Image size 2212x1662 · retinal fundus photograph · 45° field of view.
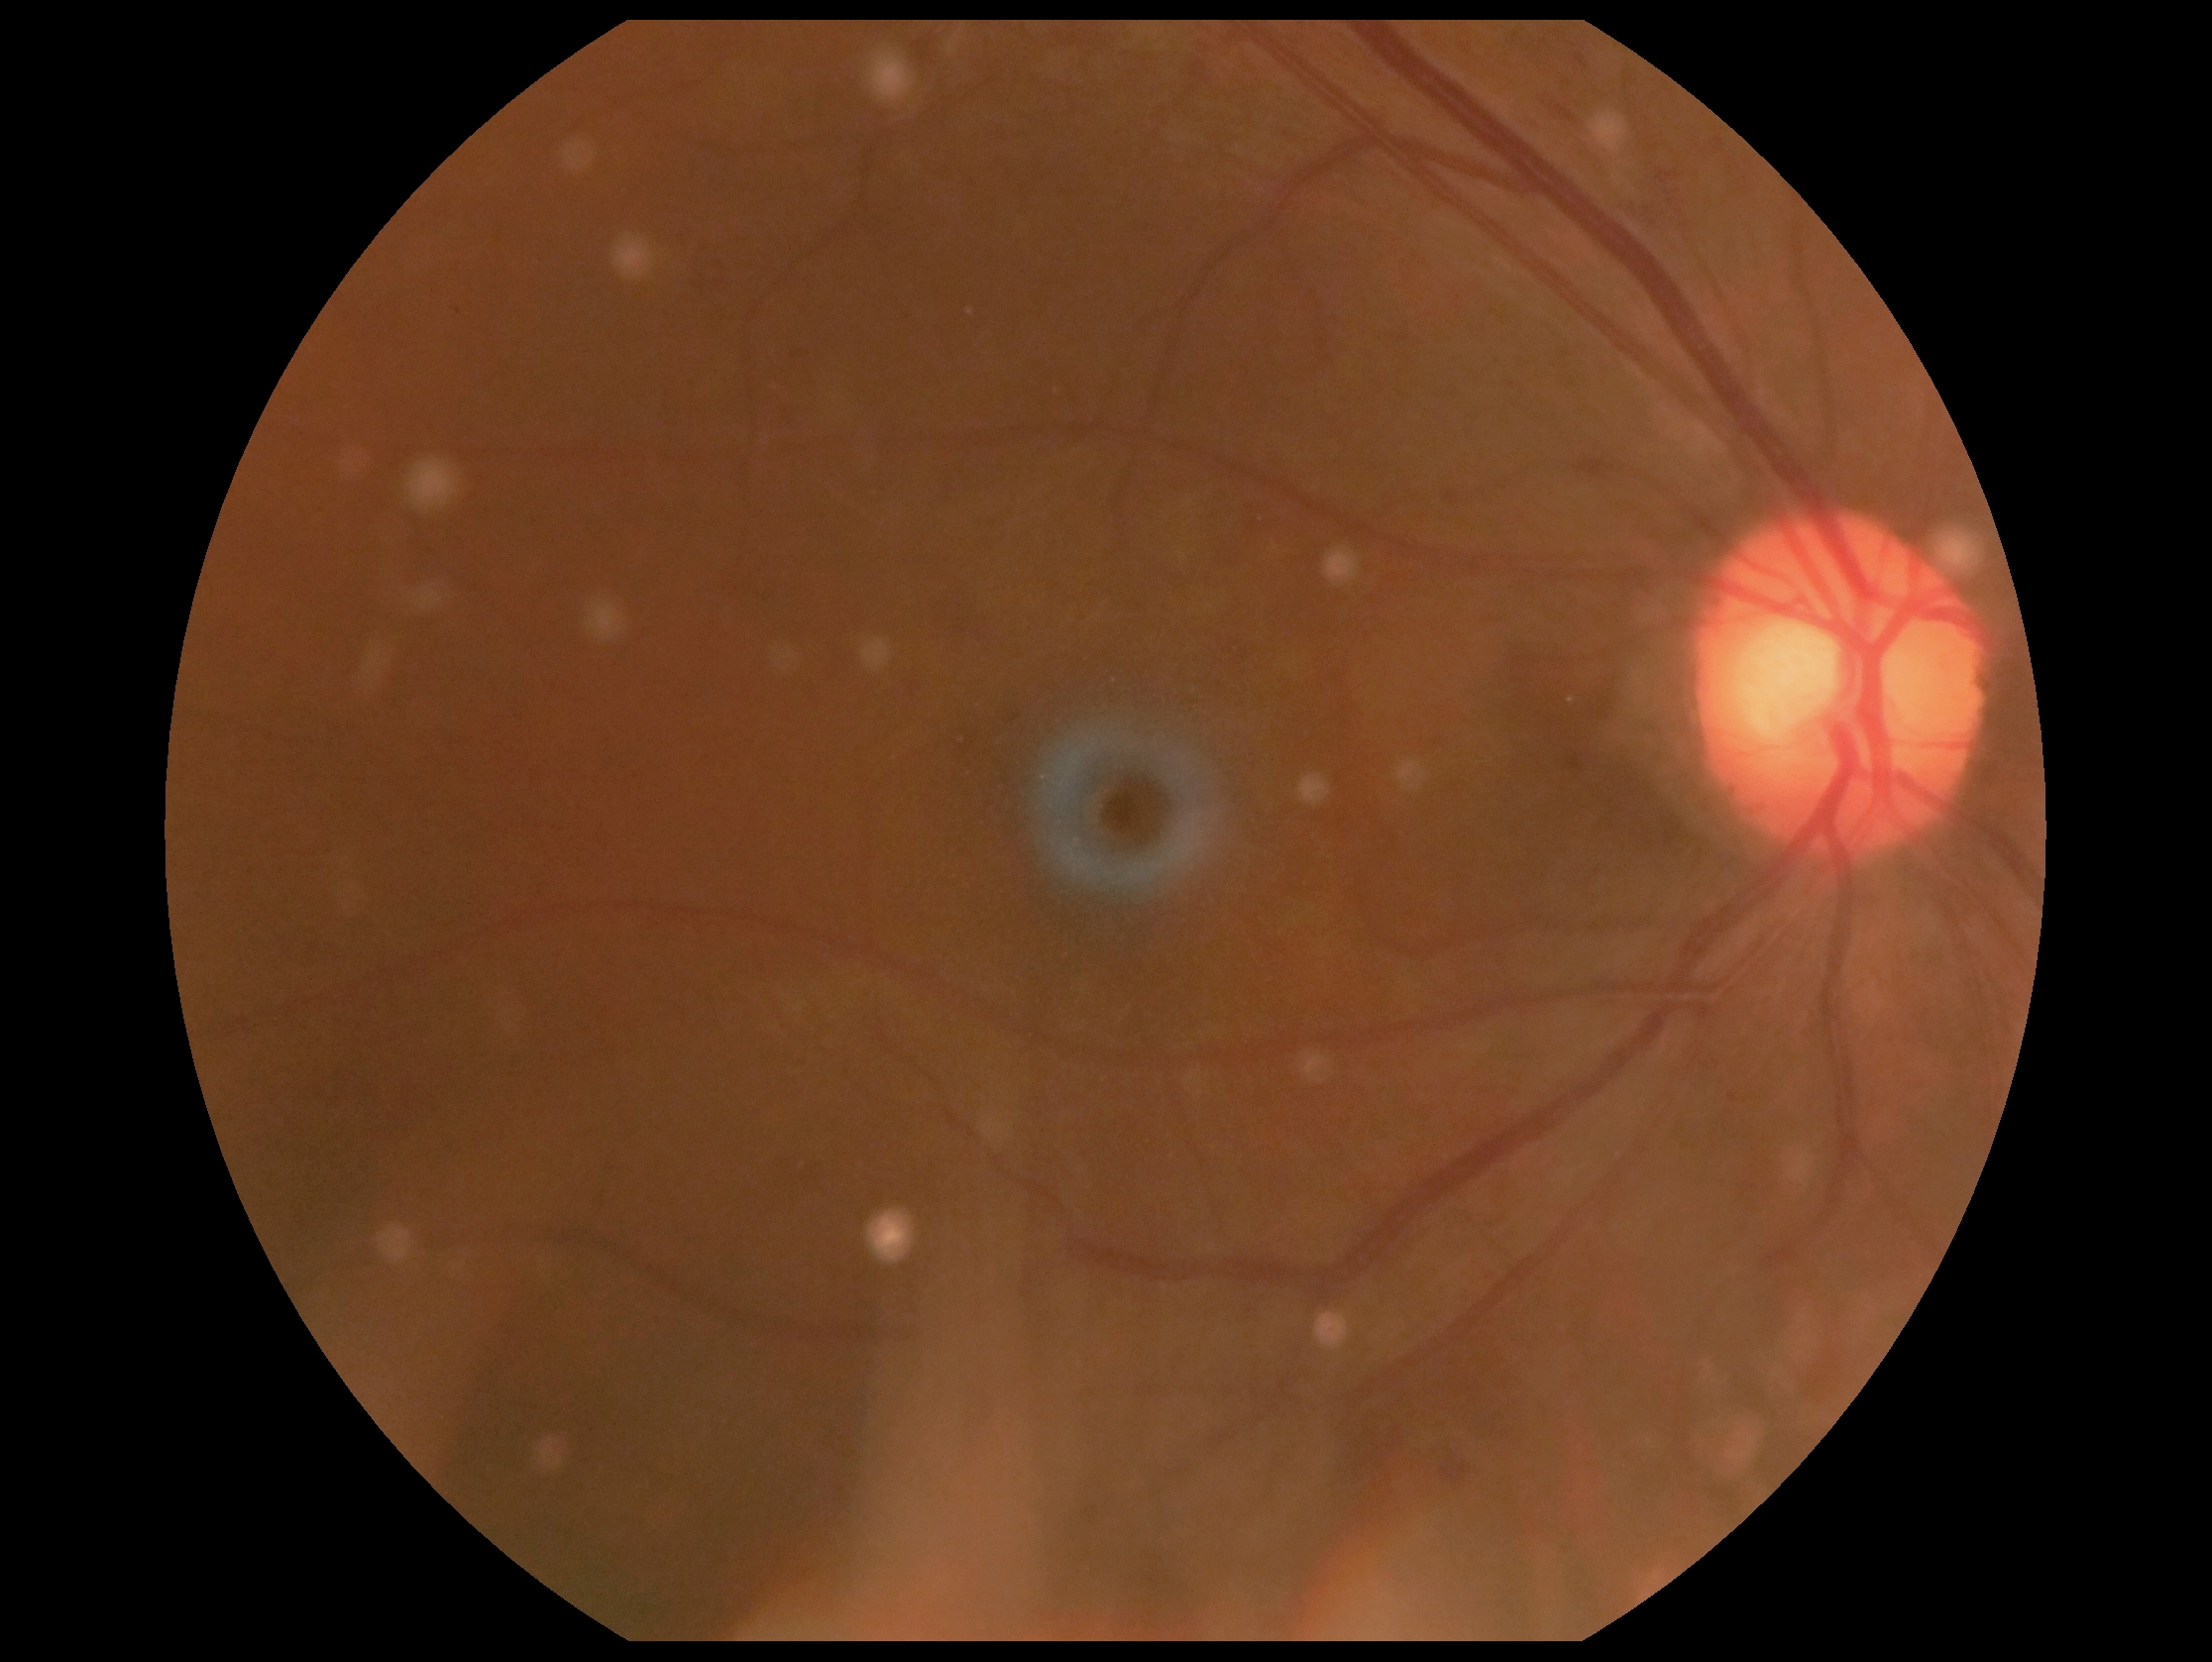

  dr_grade: 2/4